45° FOV, 2048 by 1536 pixels, retinal fundus photograph.
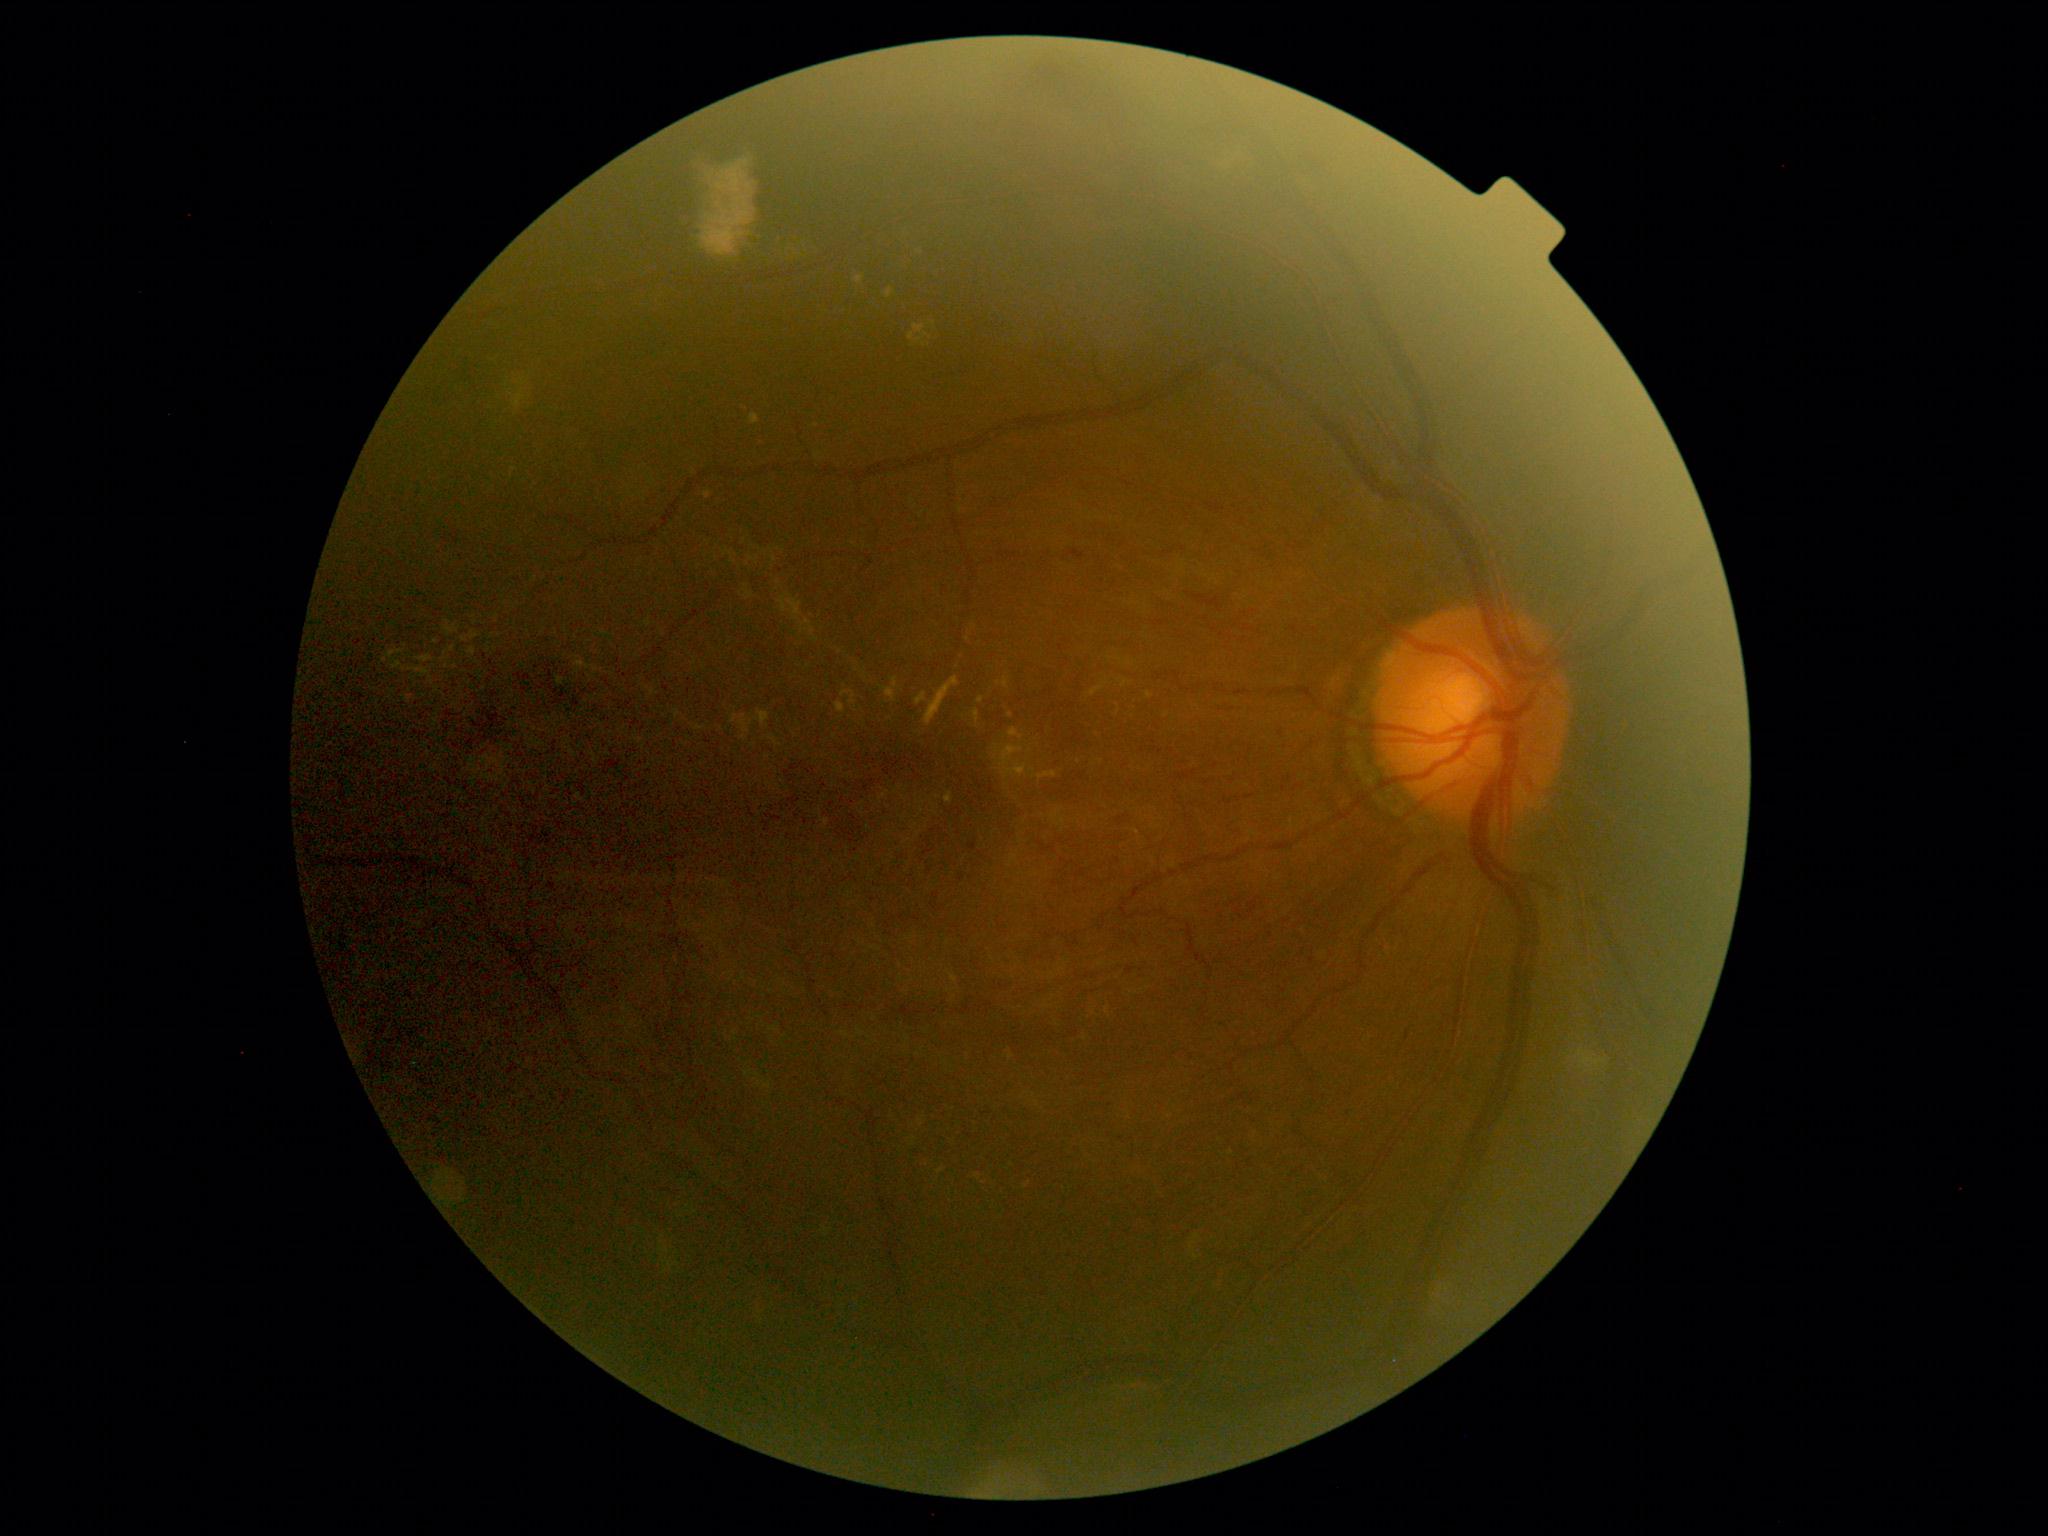
retinopathy = 2/4.